2048 x 1536 pixels. 45° field of view. Color fundus photograph: 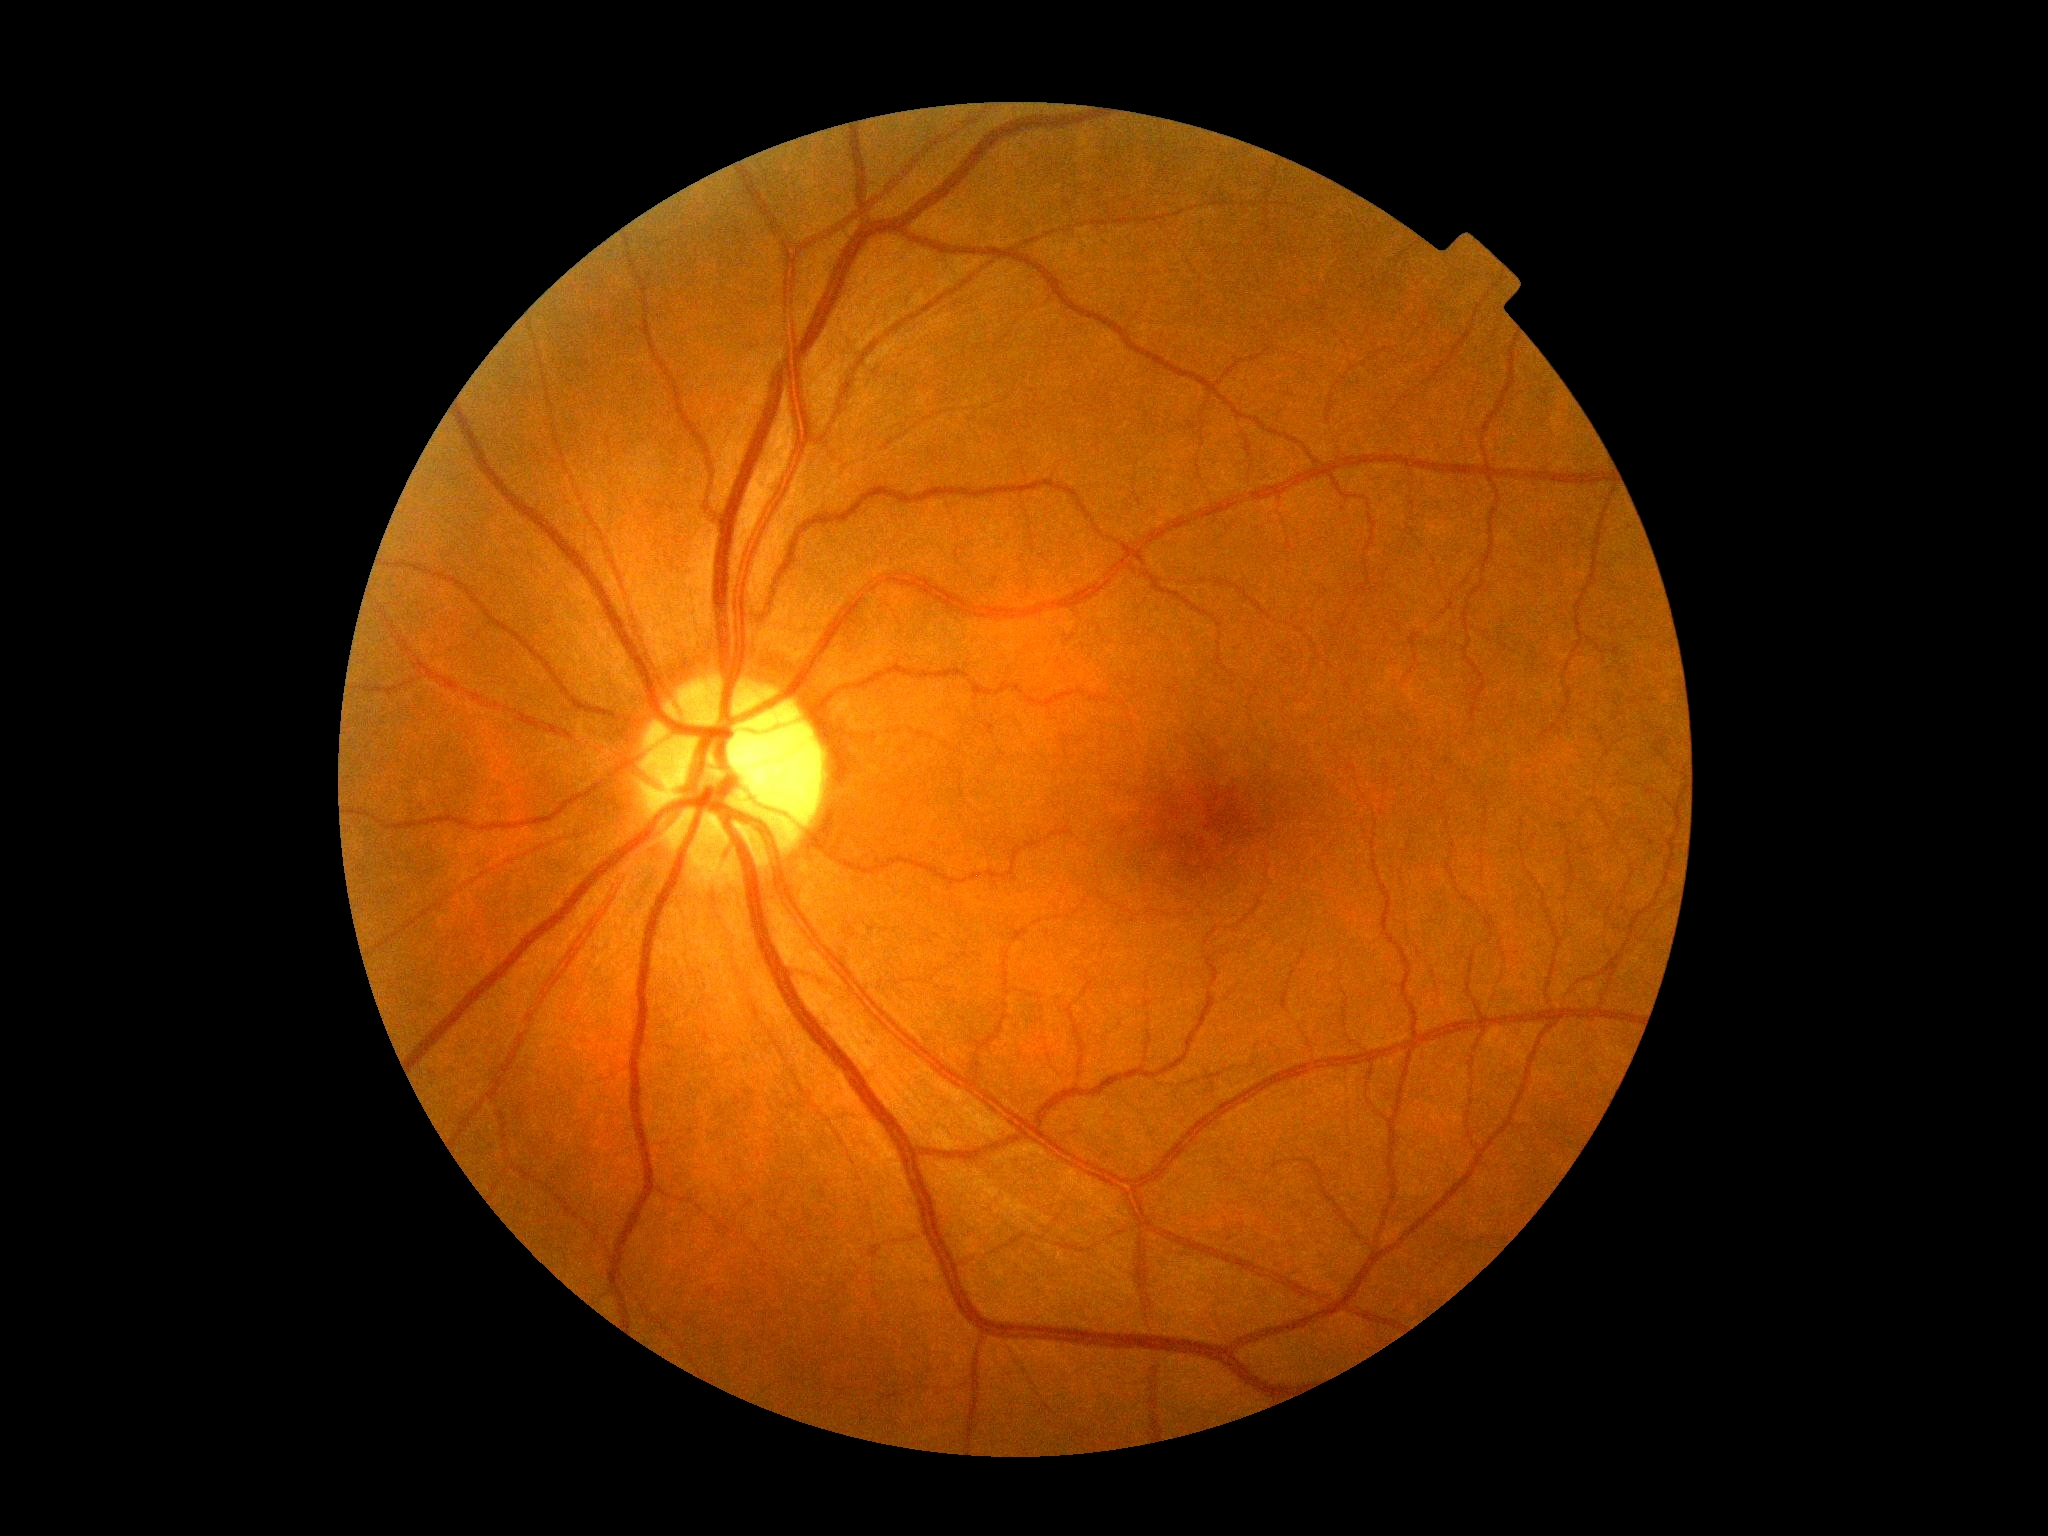 DR grade@0 (no apparent retinopathy).